Pediatric retinal photograph (wide-field) · Clarity RetCam 3, 130° FOV · 640x480
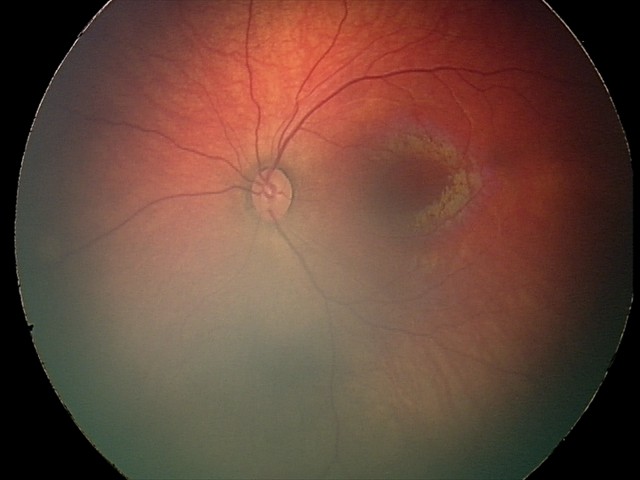

Screening examination consistent with retinal hemorrhages.